Infant wide-field retinal image; Clarity RetCam 3, 130° FOV — 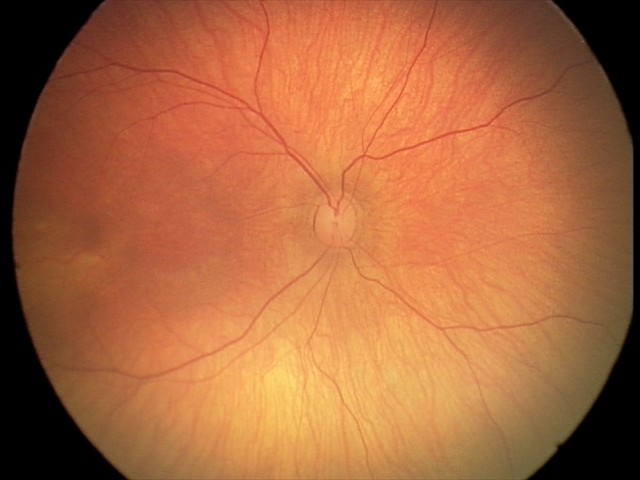

Screening examination diagnosed as physiological.